Intraocular pressure (IOP) 14 mmHg by non-contact tonometry · color fundus photograph · woman · Topcon TRC-NW400 · 39 years old · refractive error: sphere -0.75 D, cylinder -0.25 D, axis 110° · corneal thickness 468 µm · axial length (AL) 24 mm · 2212 x 1661 pixels
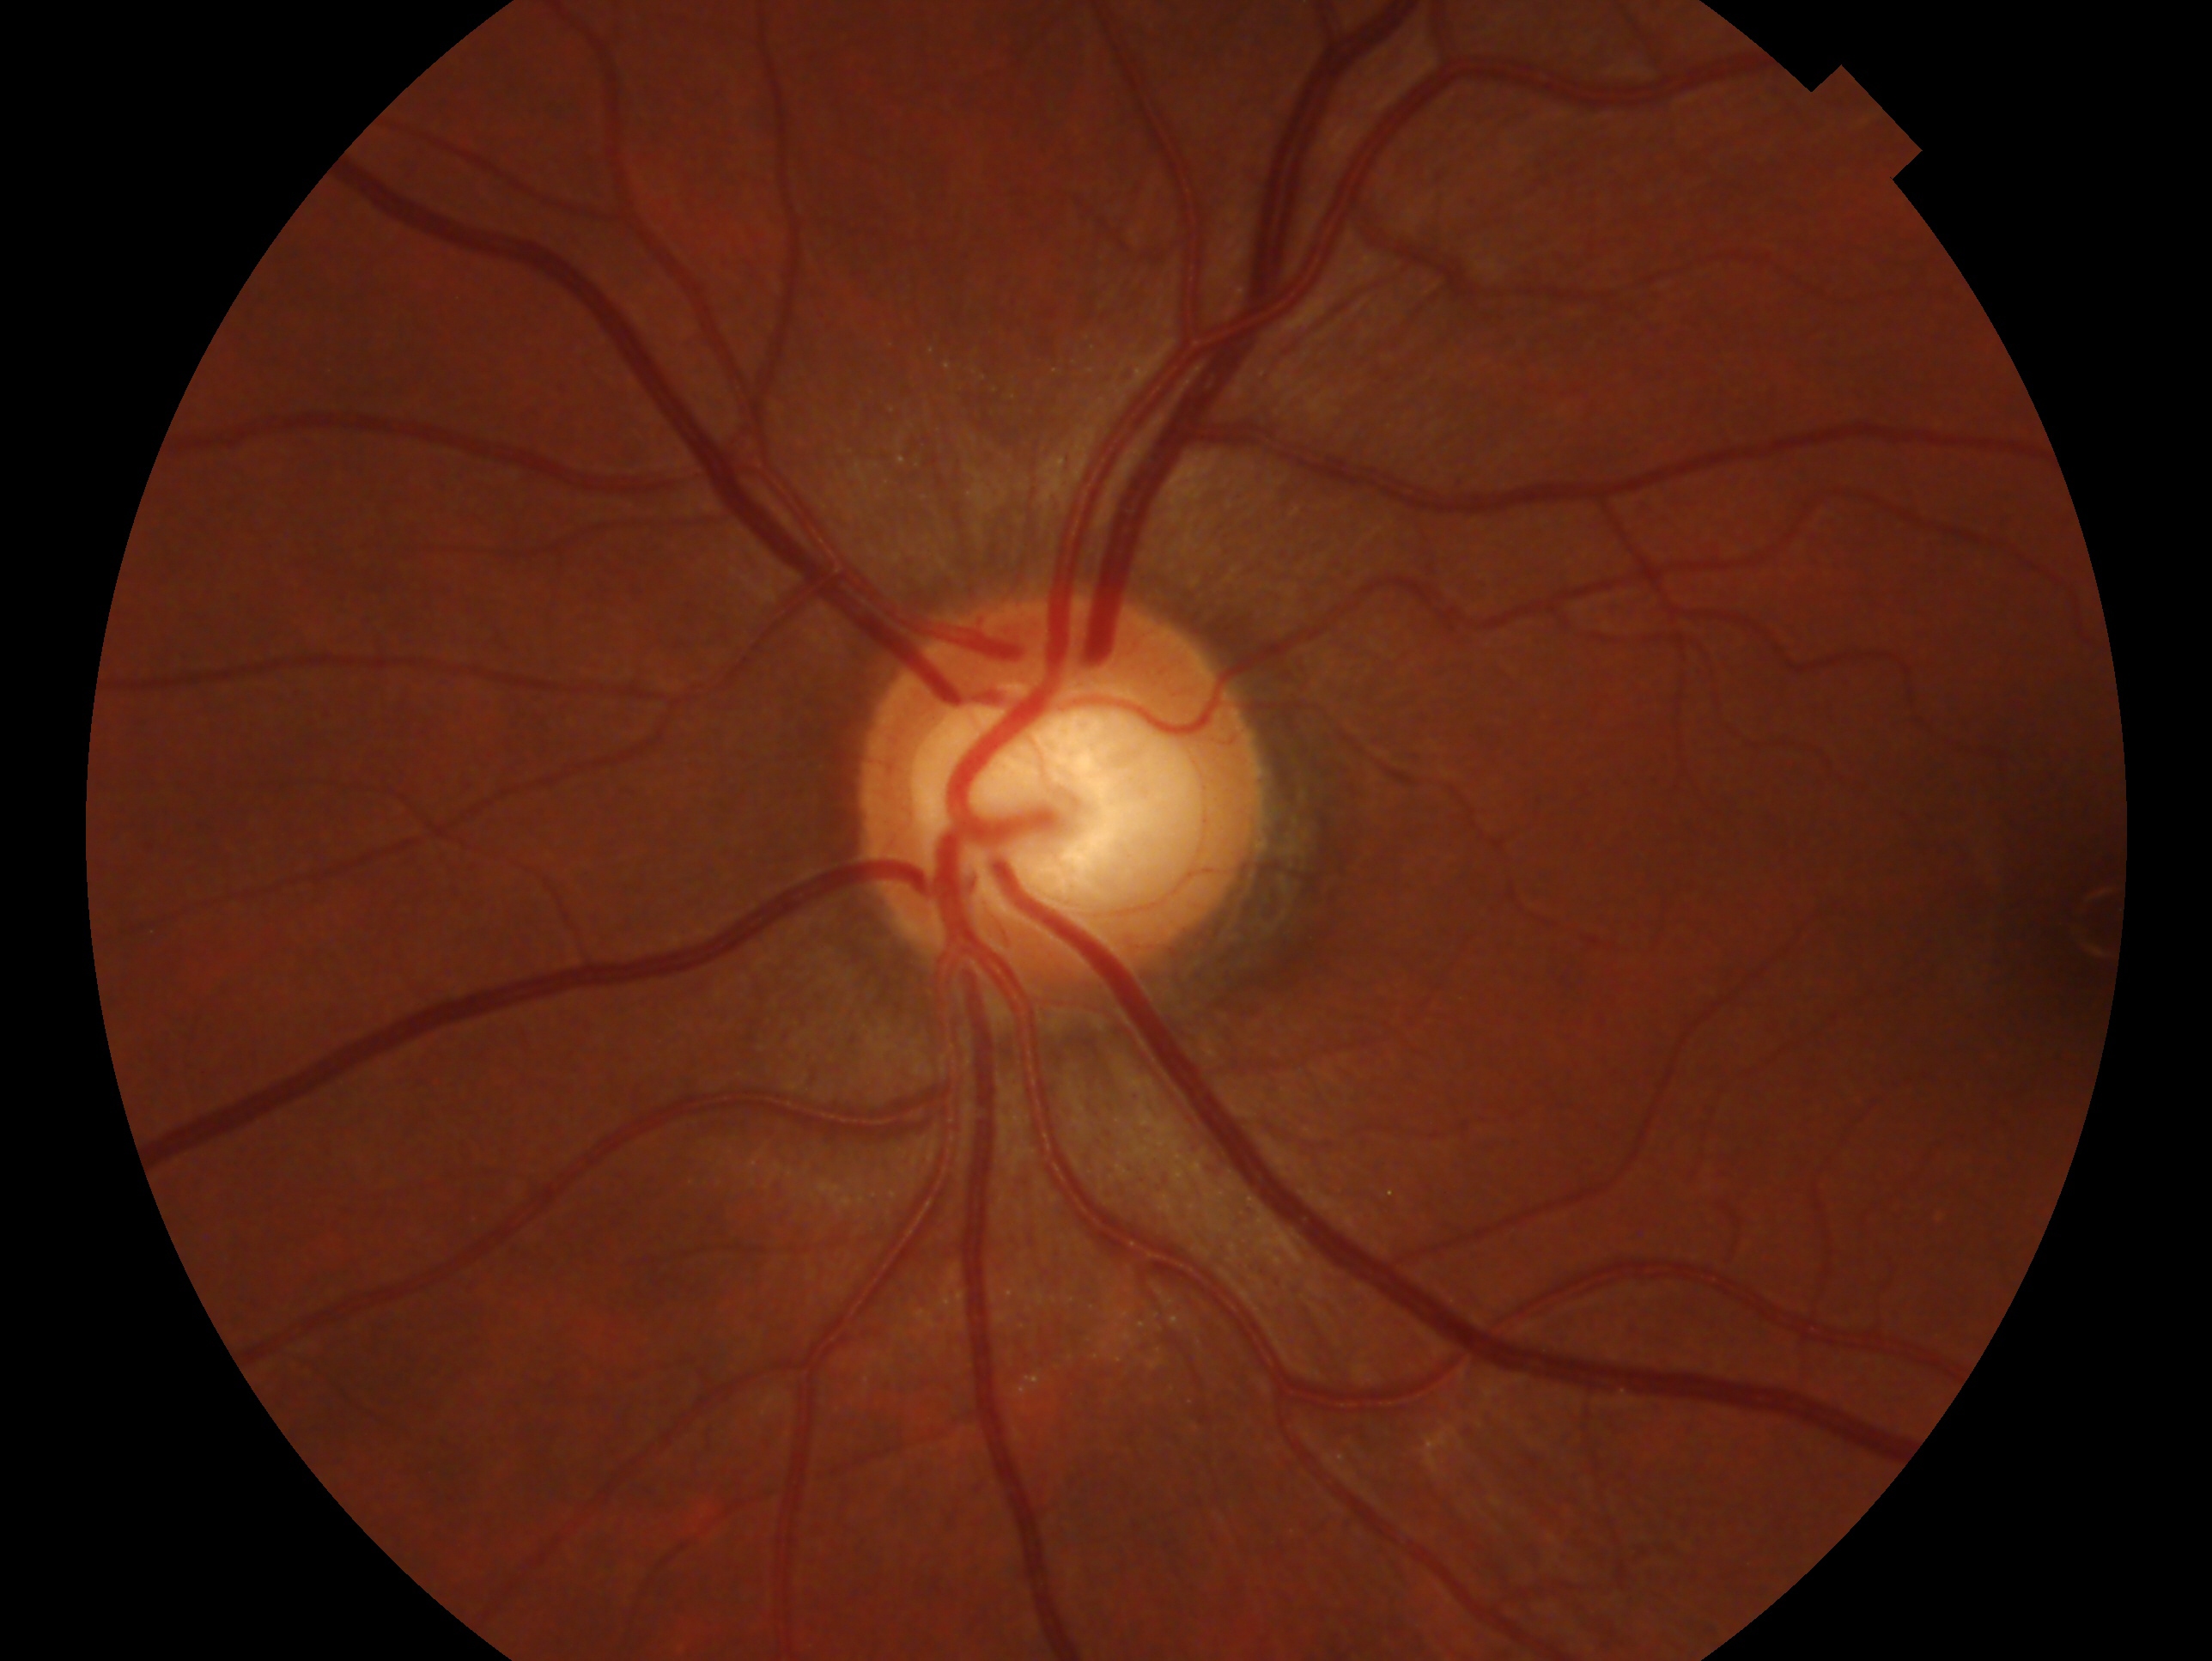 Findings:
* laterality: left
* clinical classification: no glaucoma